Nonmydriatic fundus photograph · NIDEK AFC-230 fundus camera · modified Davis classification: 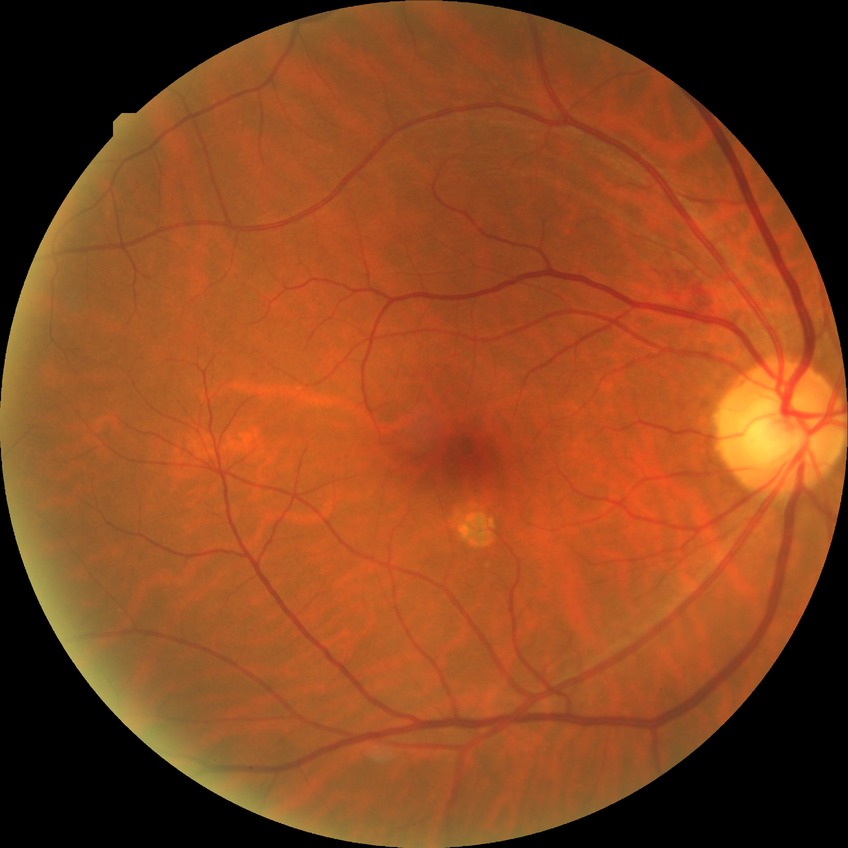 Diabetic retinopathy (DR) is no diabetic retinopathy (NDR).